Graded on the modified Davis scale
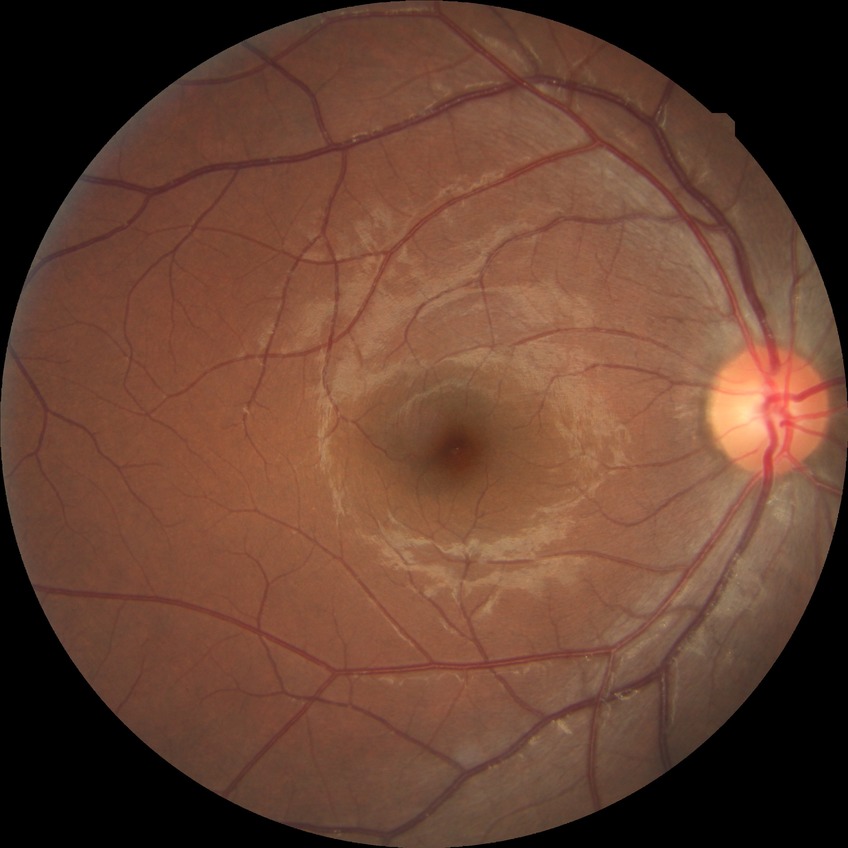
diabetic retinopathy (DR)@no diabetic retinopathy (NDR).